NIDEK AFC-230 fundus camera. Retinal fundus photograph. 848 by 848 pixels. 45° FOV.
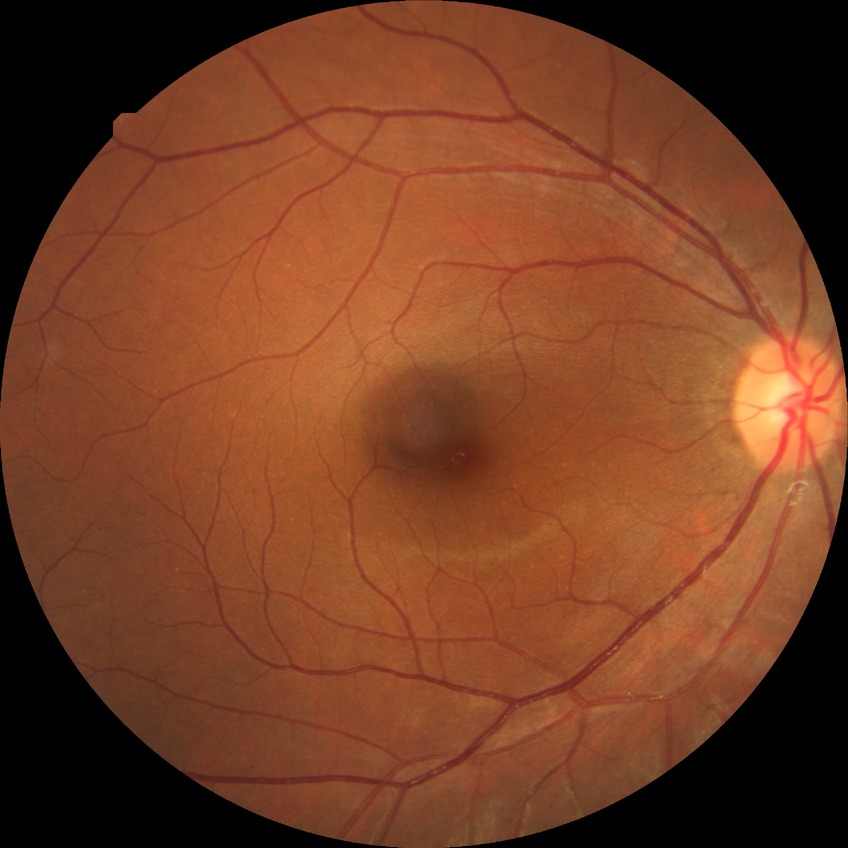
Assessment:
– retinopathy grade: no diabetic retinopathy